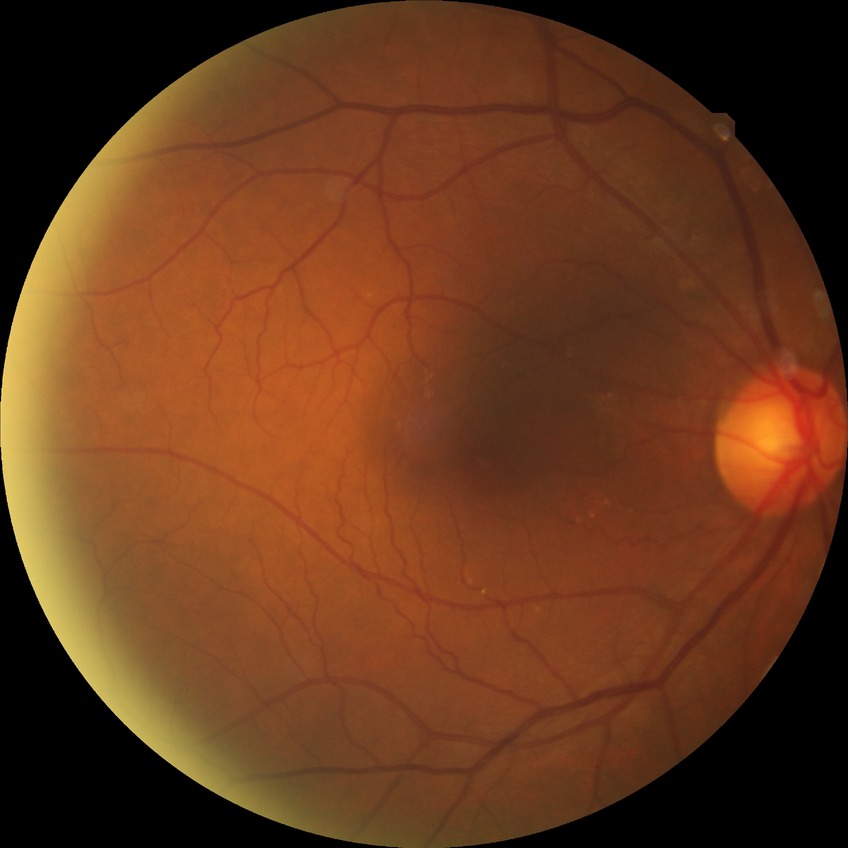 No diabetic retinal disease findings. DR severity: NDR.